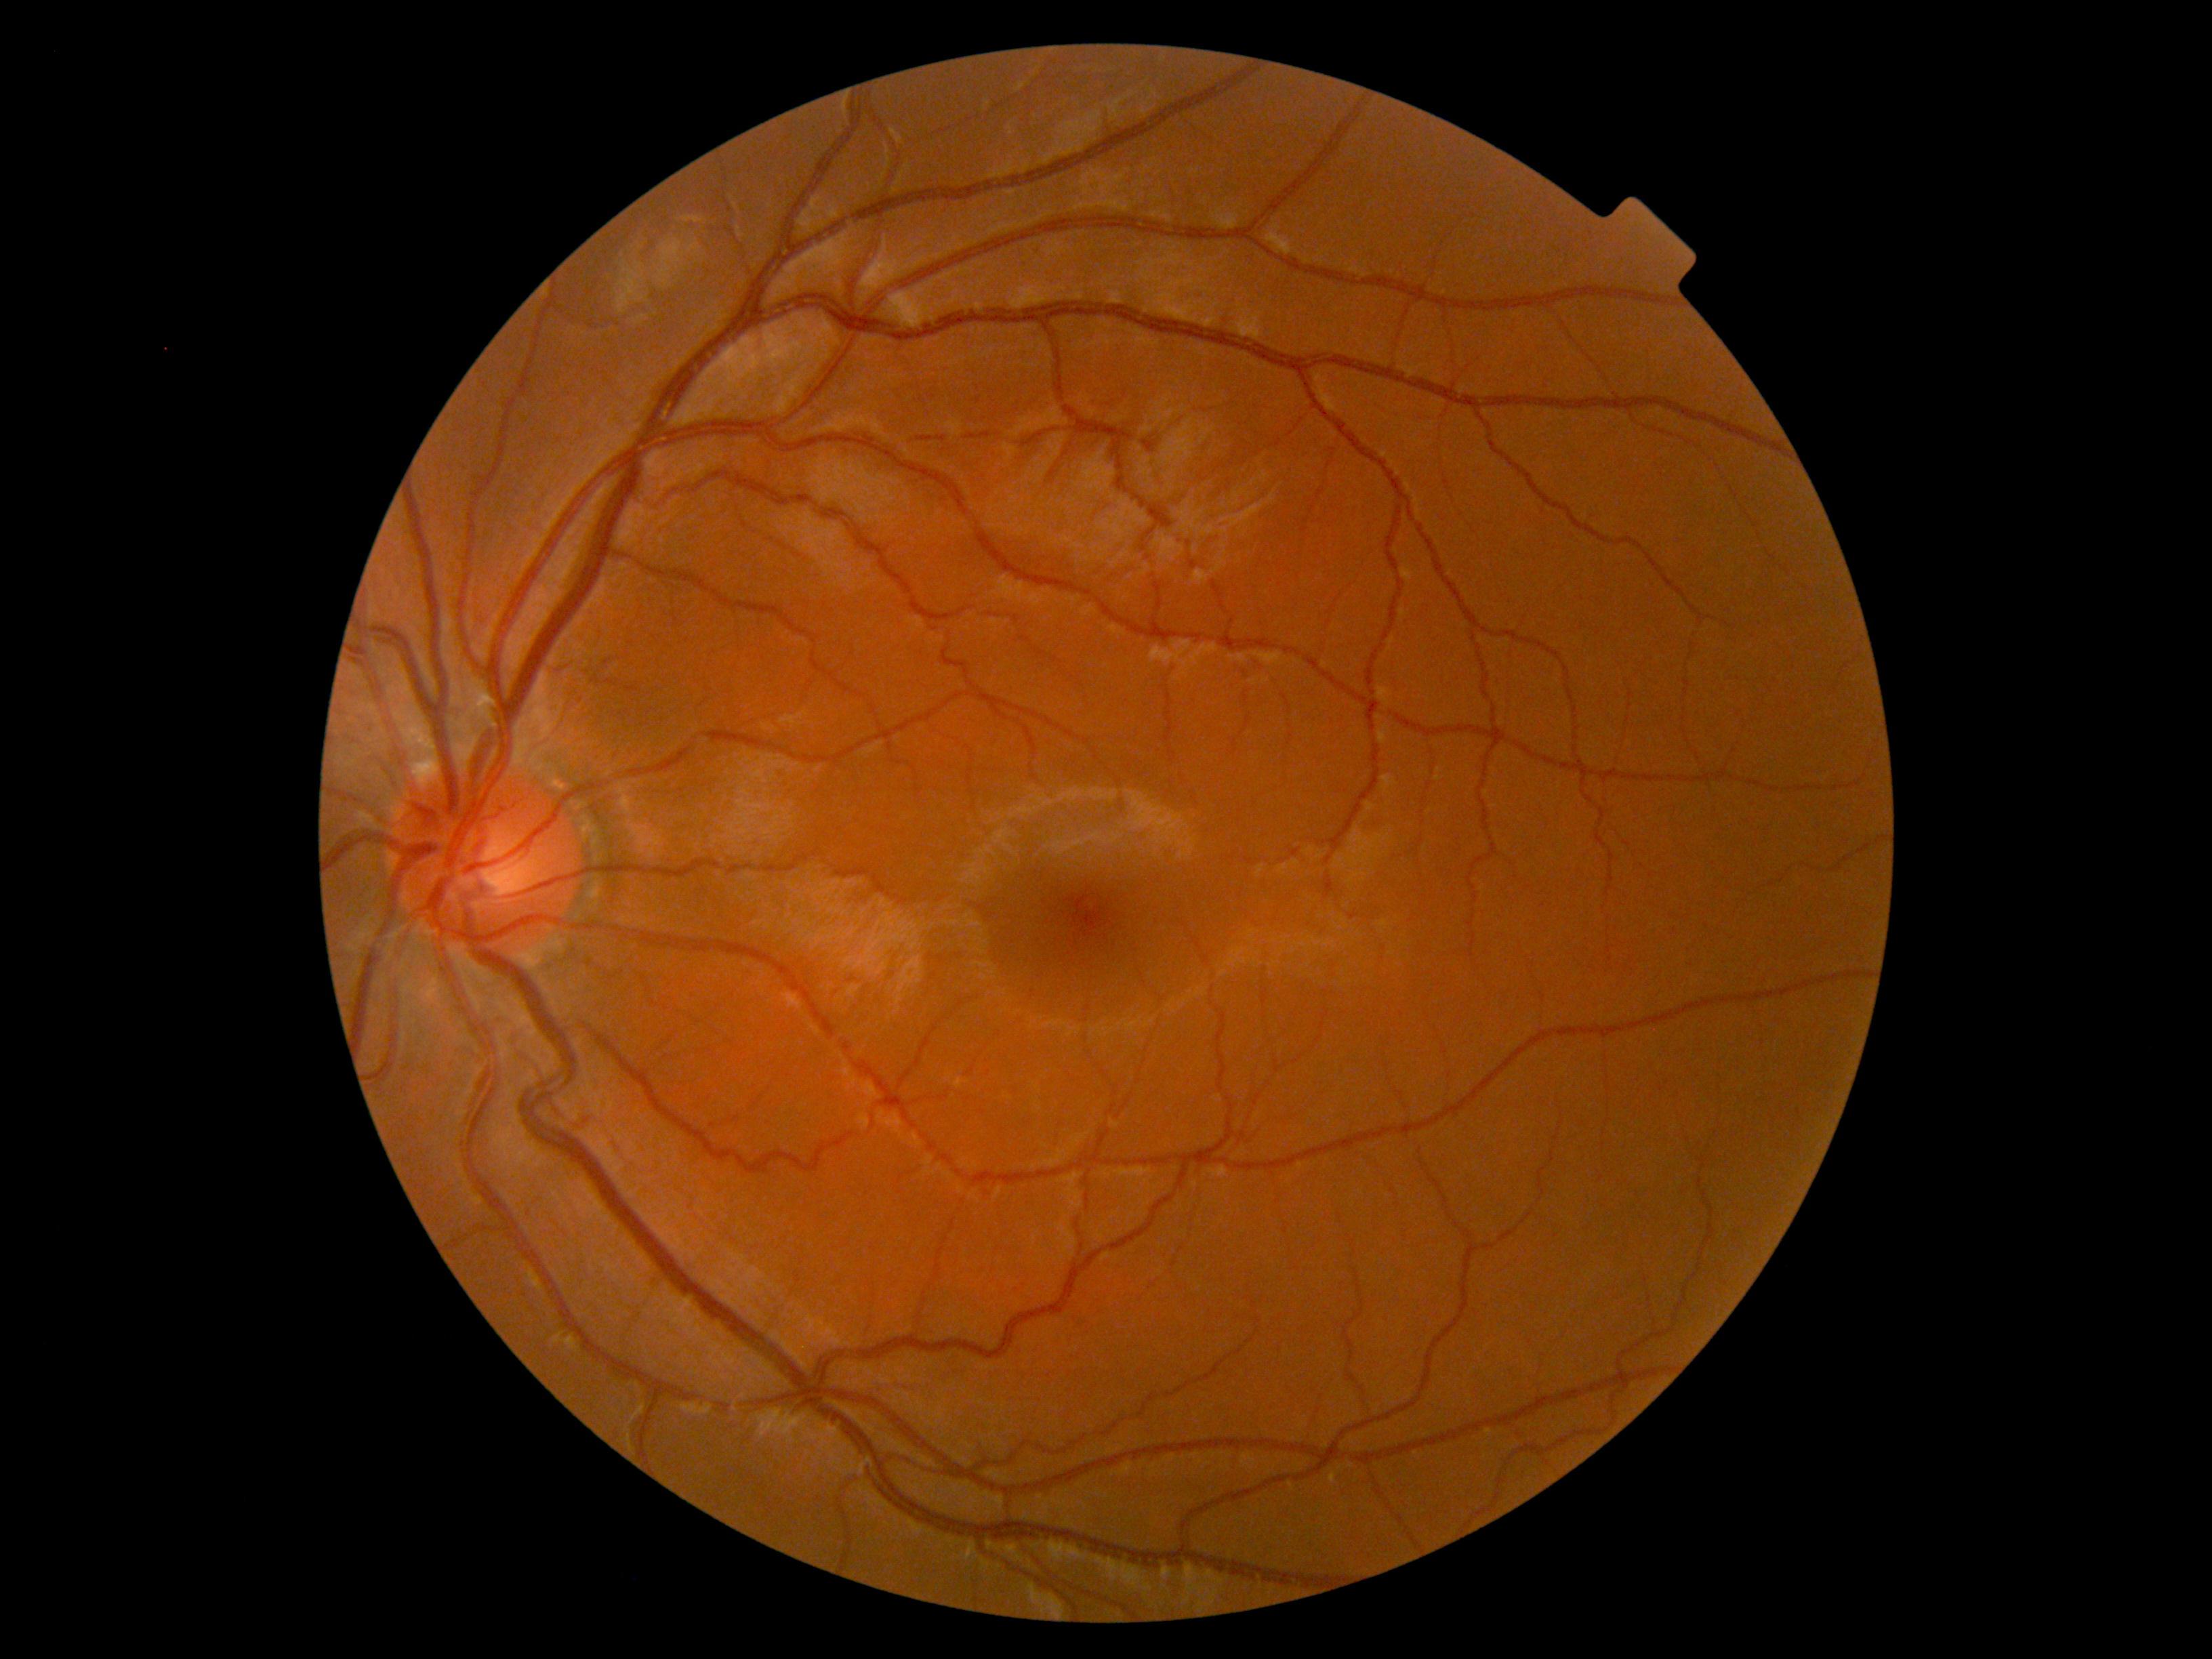
No DR findings.
Retinopathy is no apparent retinopathy (grade 0).